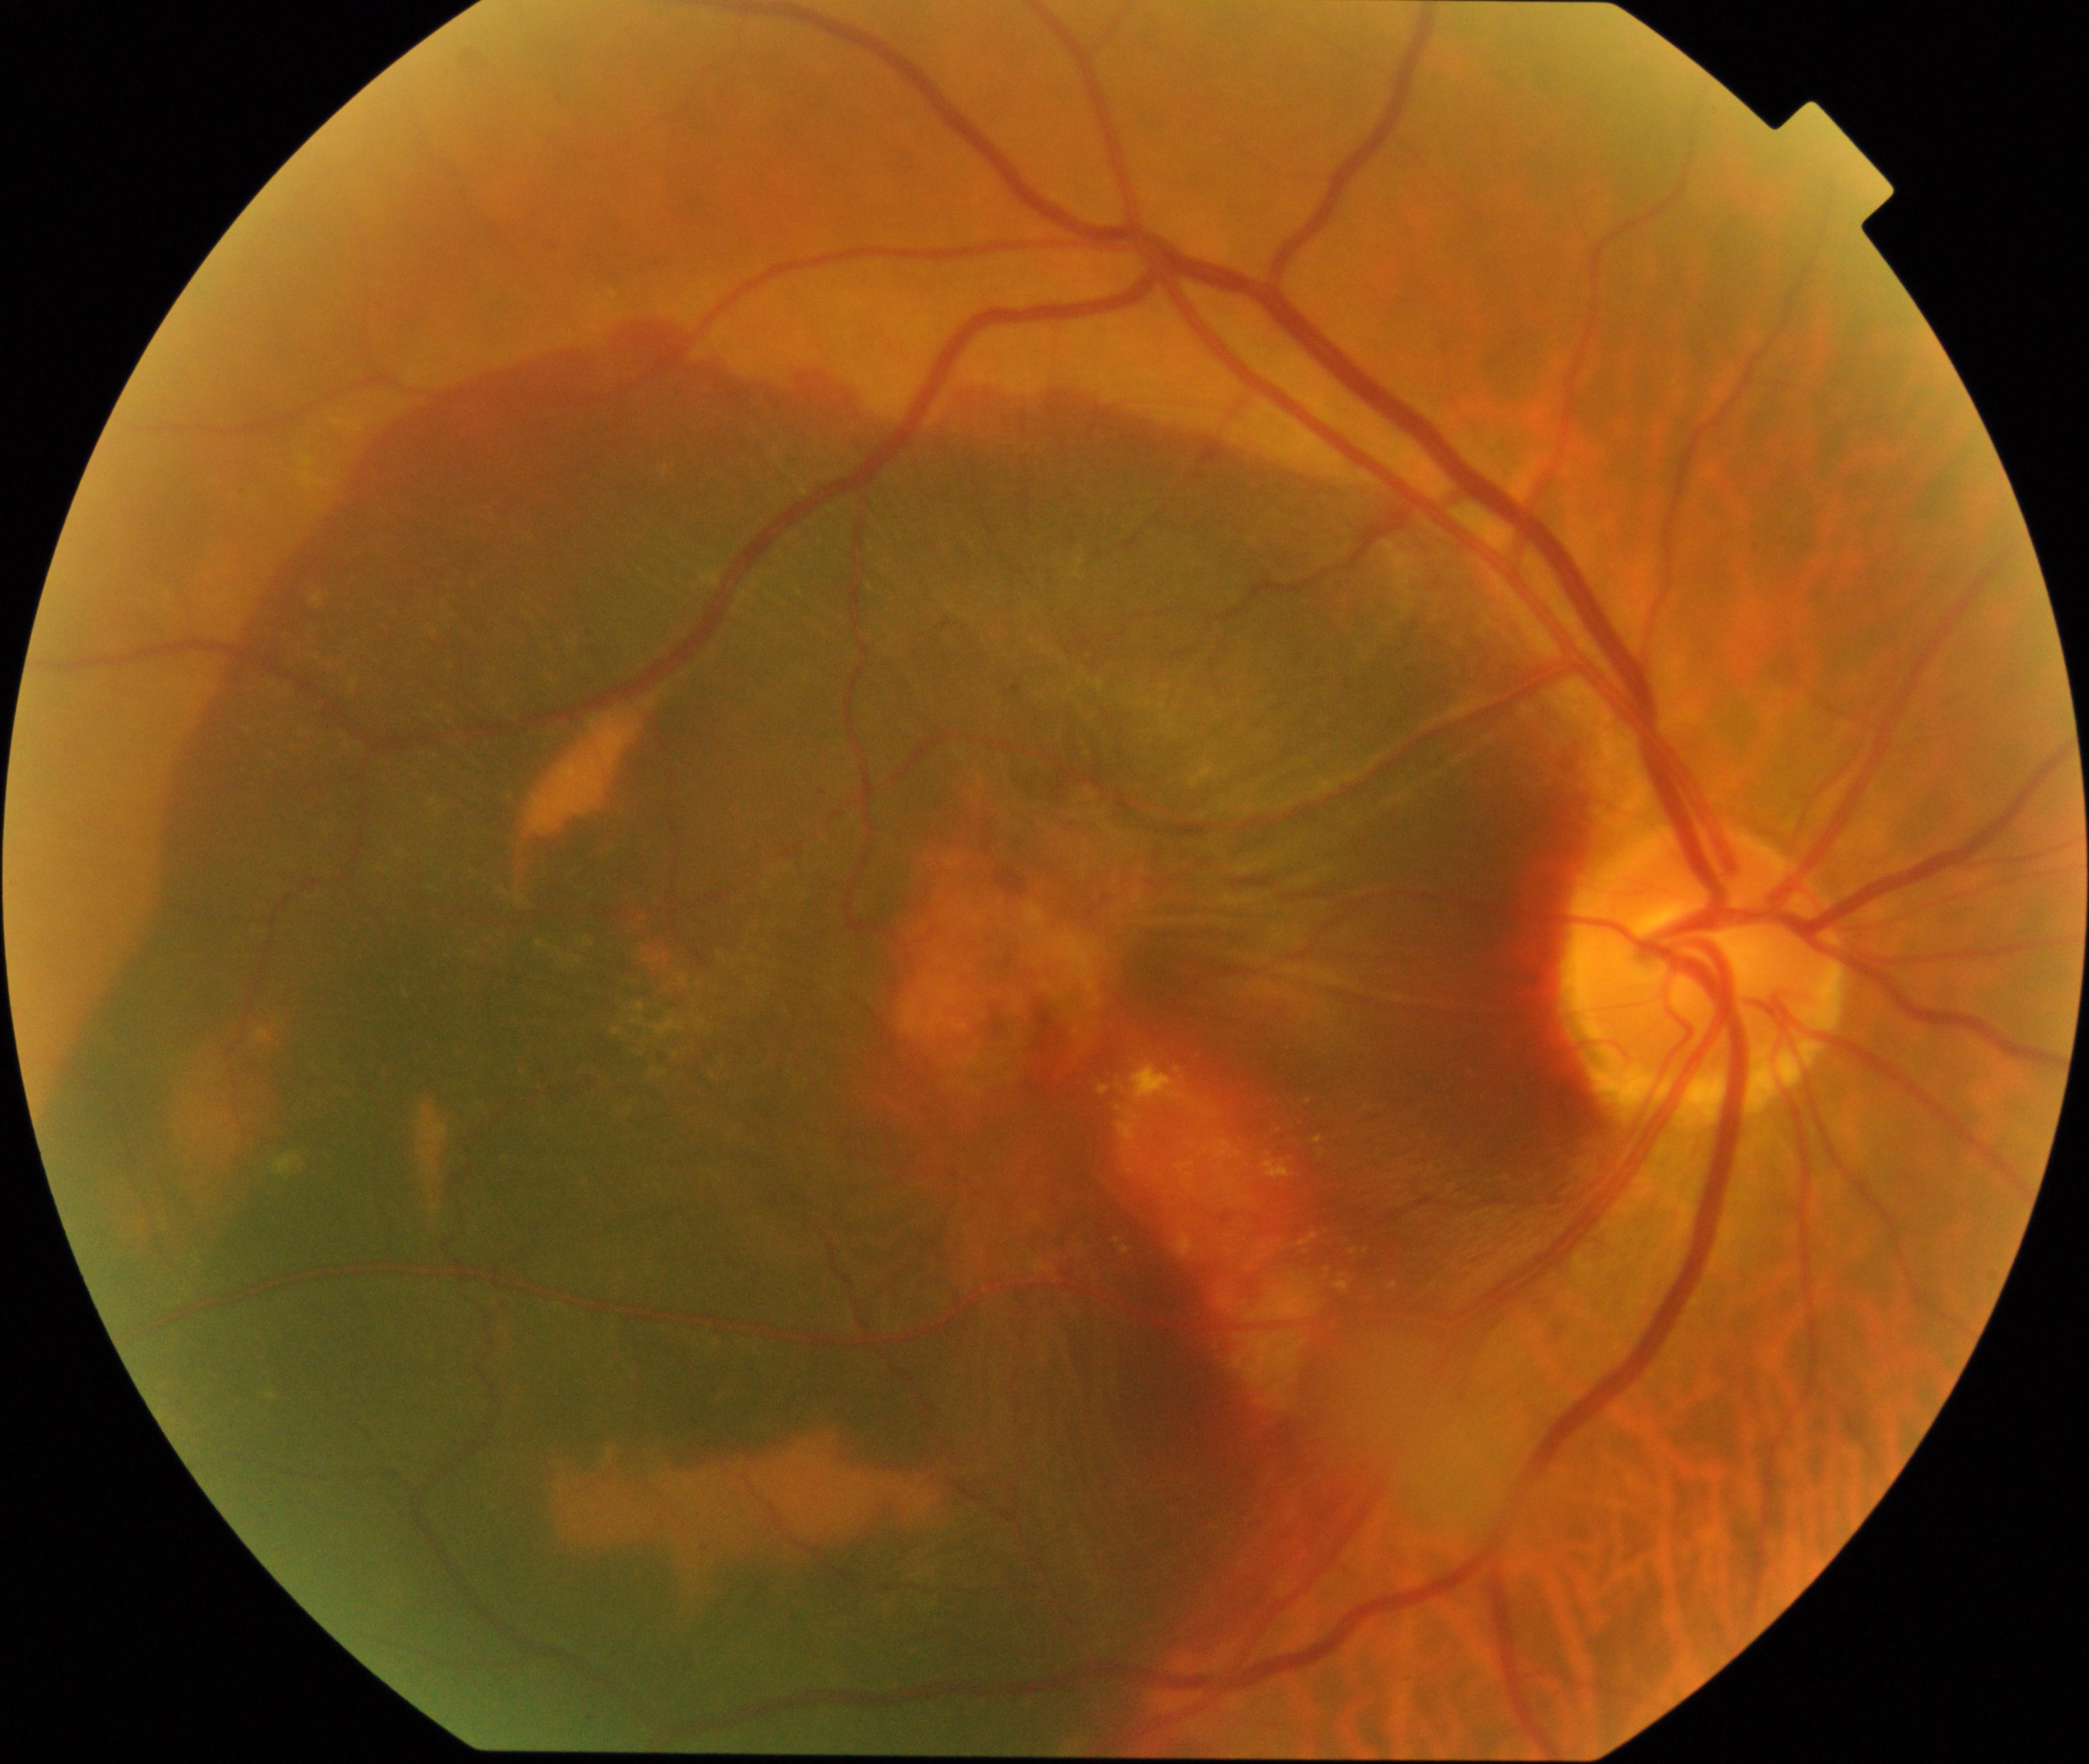 Color fundus photograph showing maculopathy.